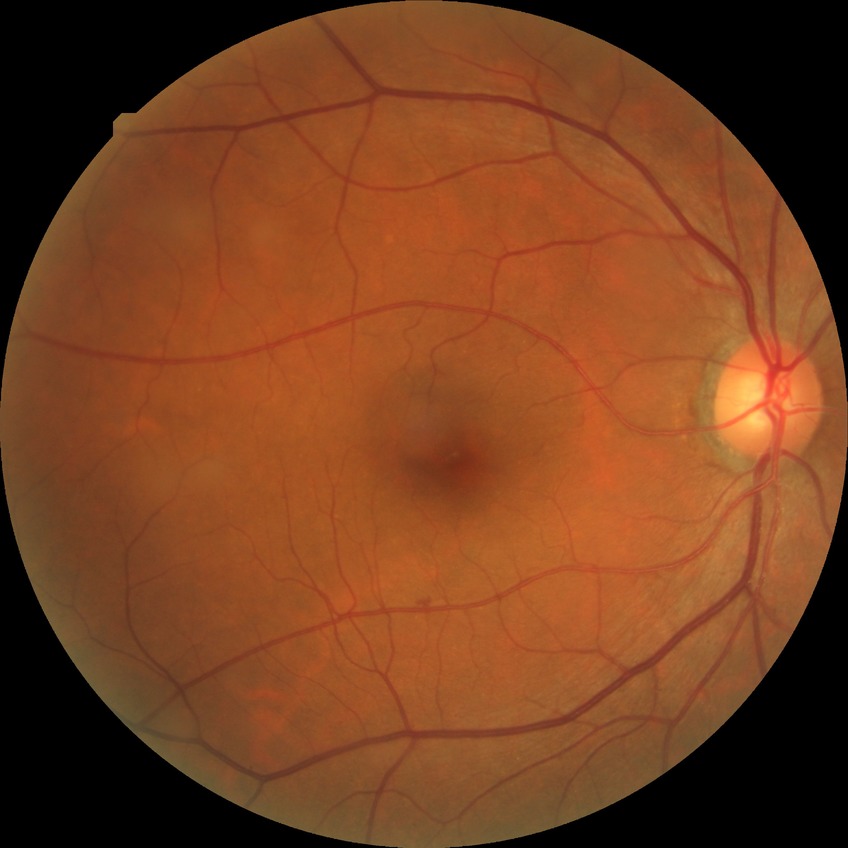
Retinopathy grade is no diabetic retinopathy.